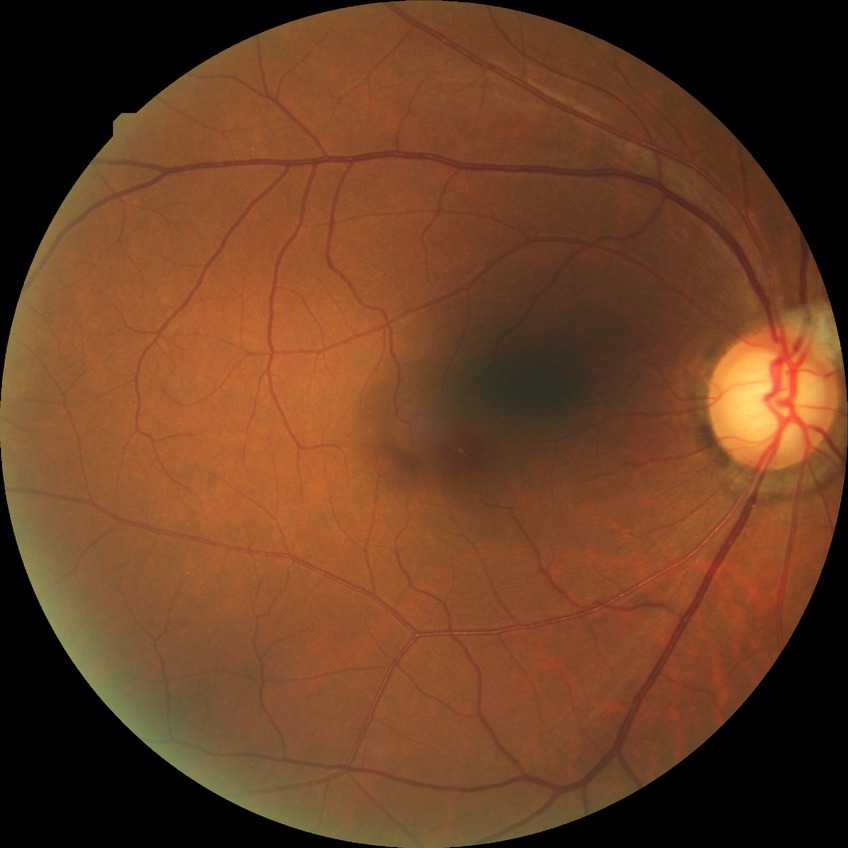 retinopathy grade: no diabetic retinopathy.